Infant wide-field retinal image.
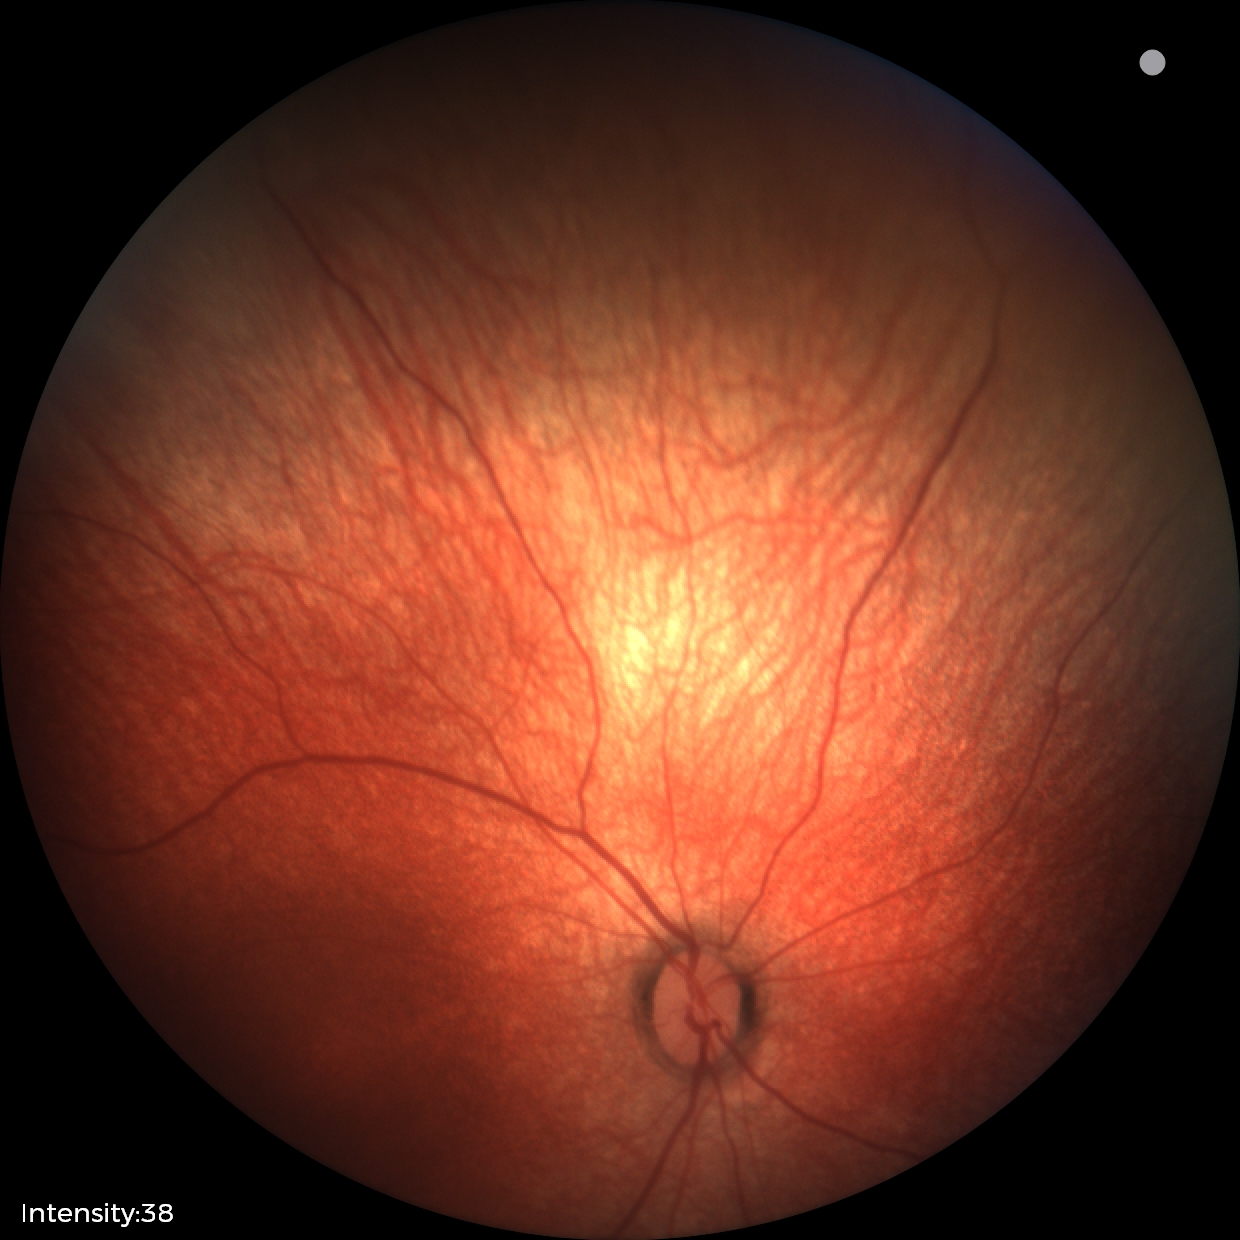

Q: What was the screening finding?
A: physiological finding